45-degree field of view, 848 x 848 pixels.
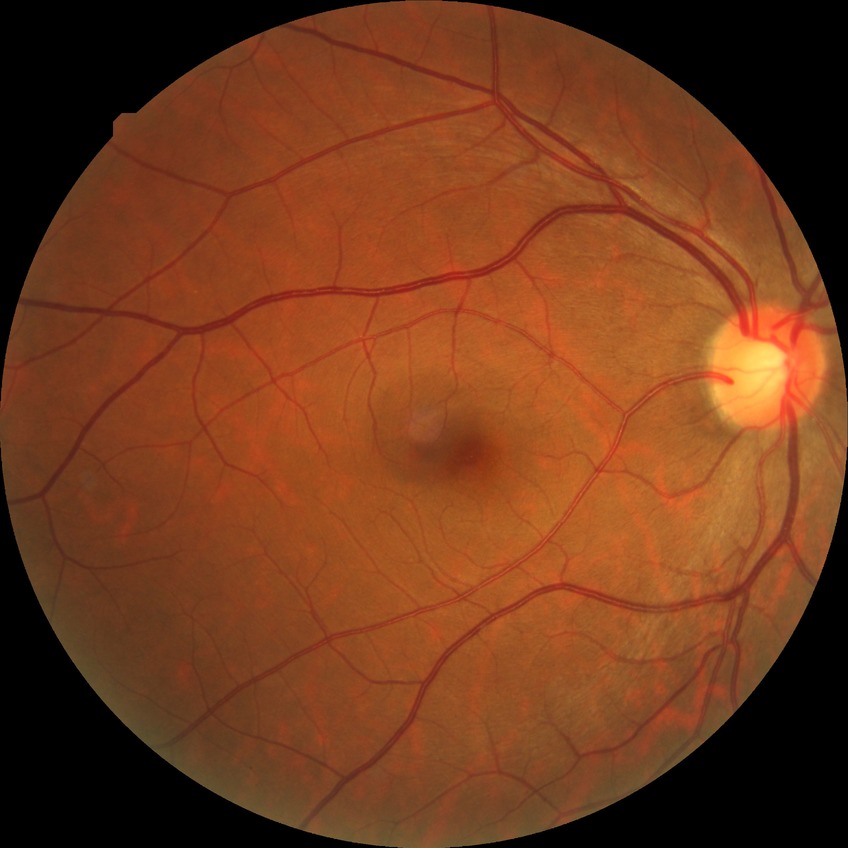

{"davis_grade": "no diabetic retinopathy (NDR)"}